Wide-field fundus photograph of an infant:
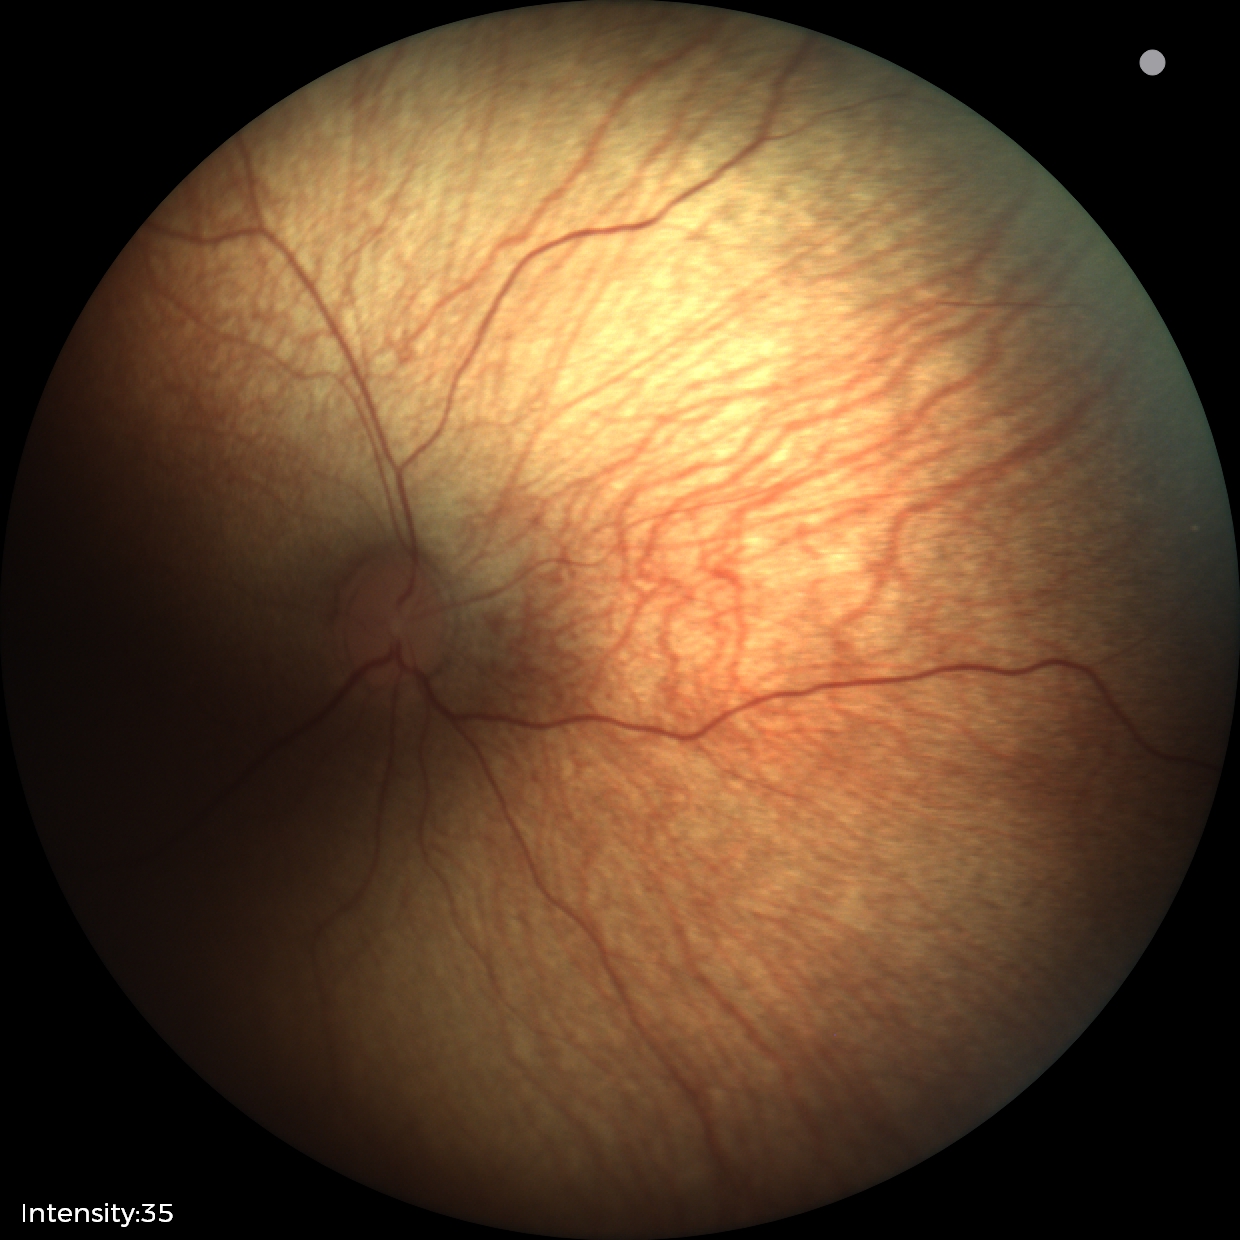

Normal screening examination.